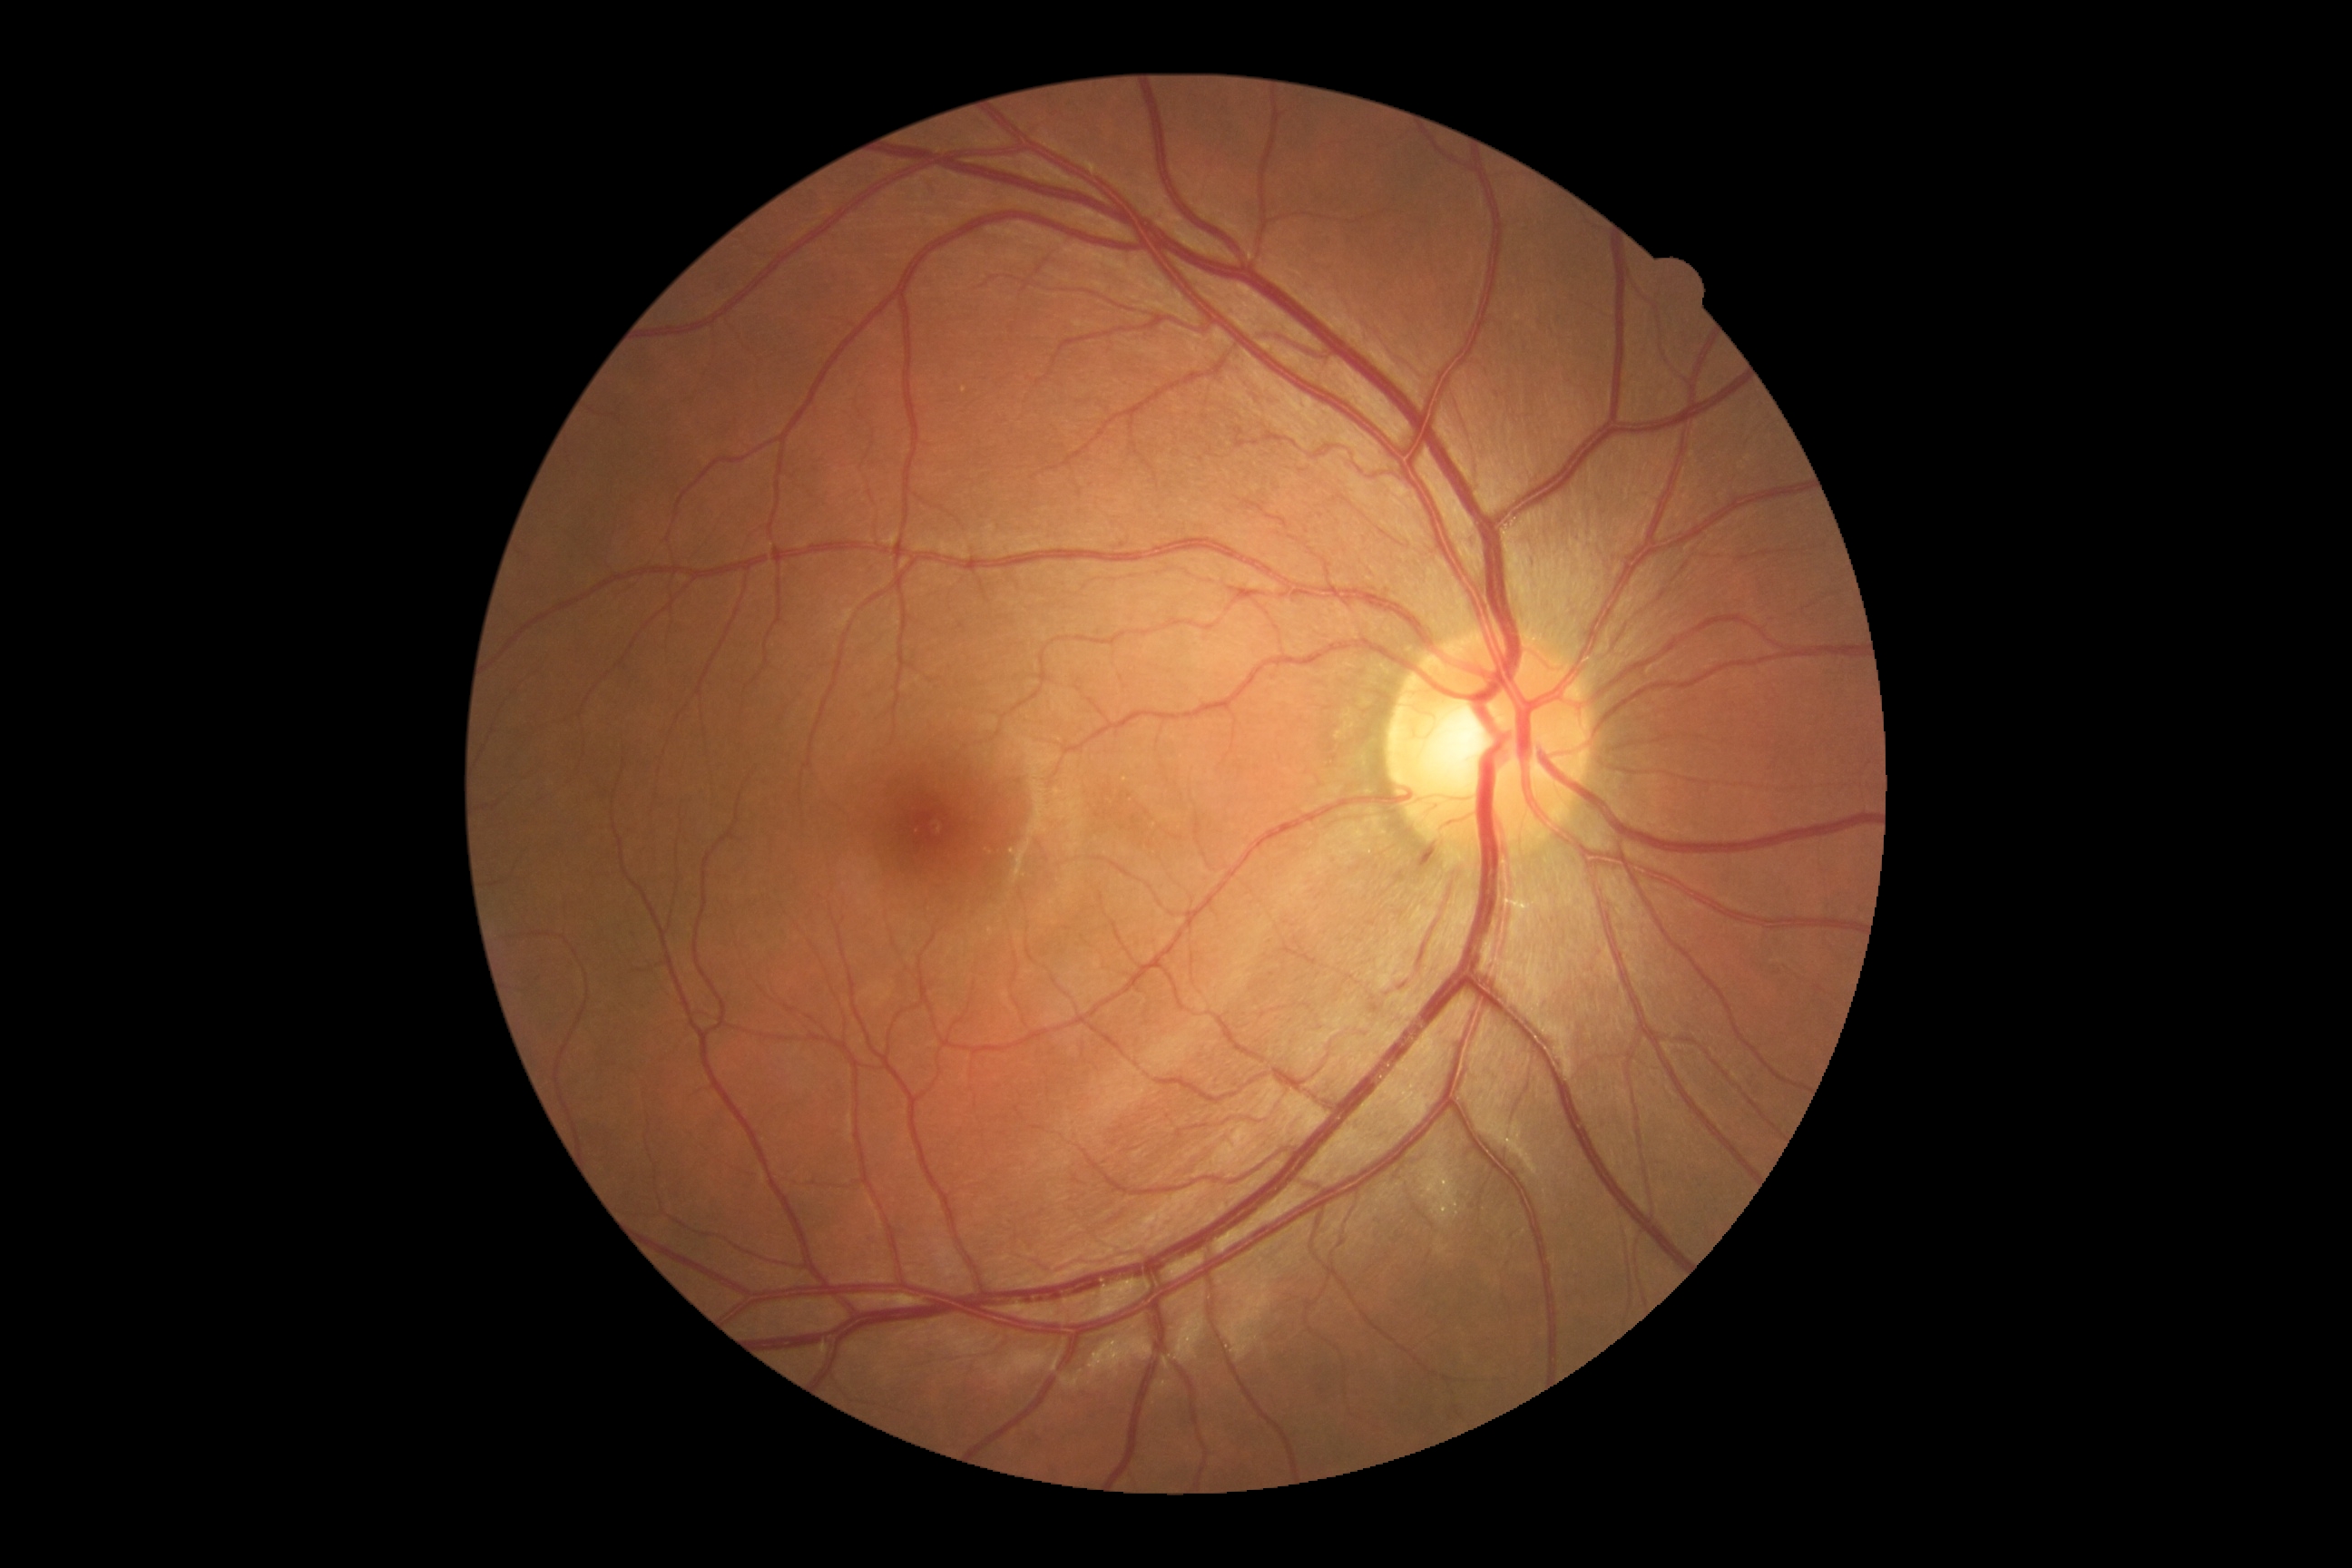
Disease class: non-proliferative diabetic retinopathy.
Diabetic retinopathy (DR) is grade 2 (moderate NPDR).